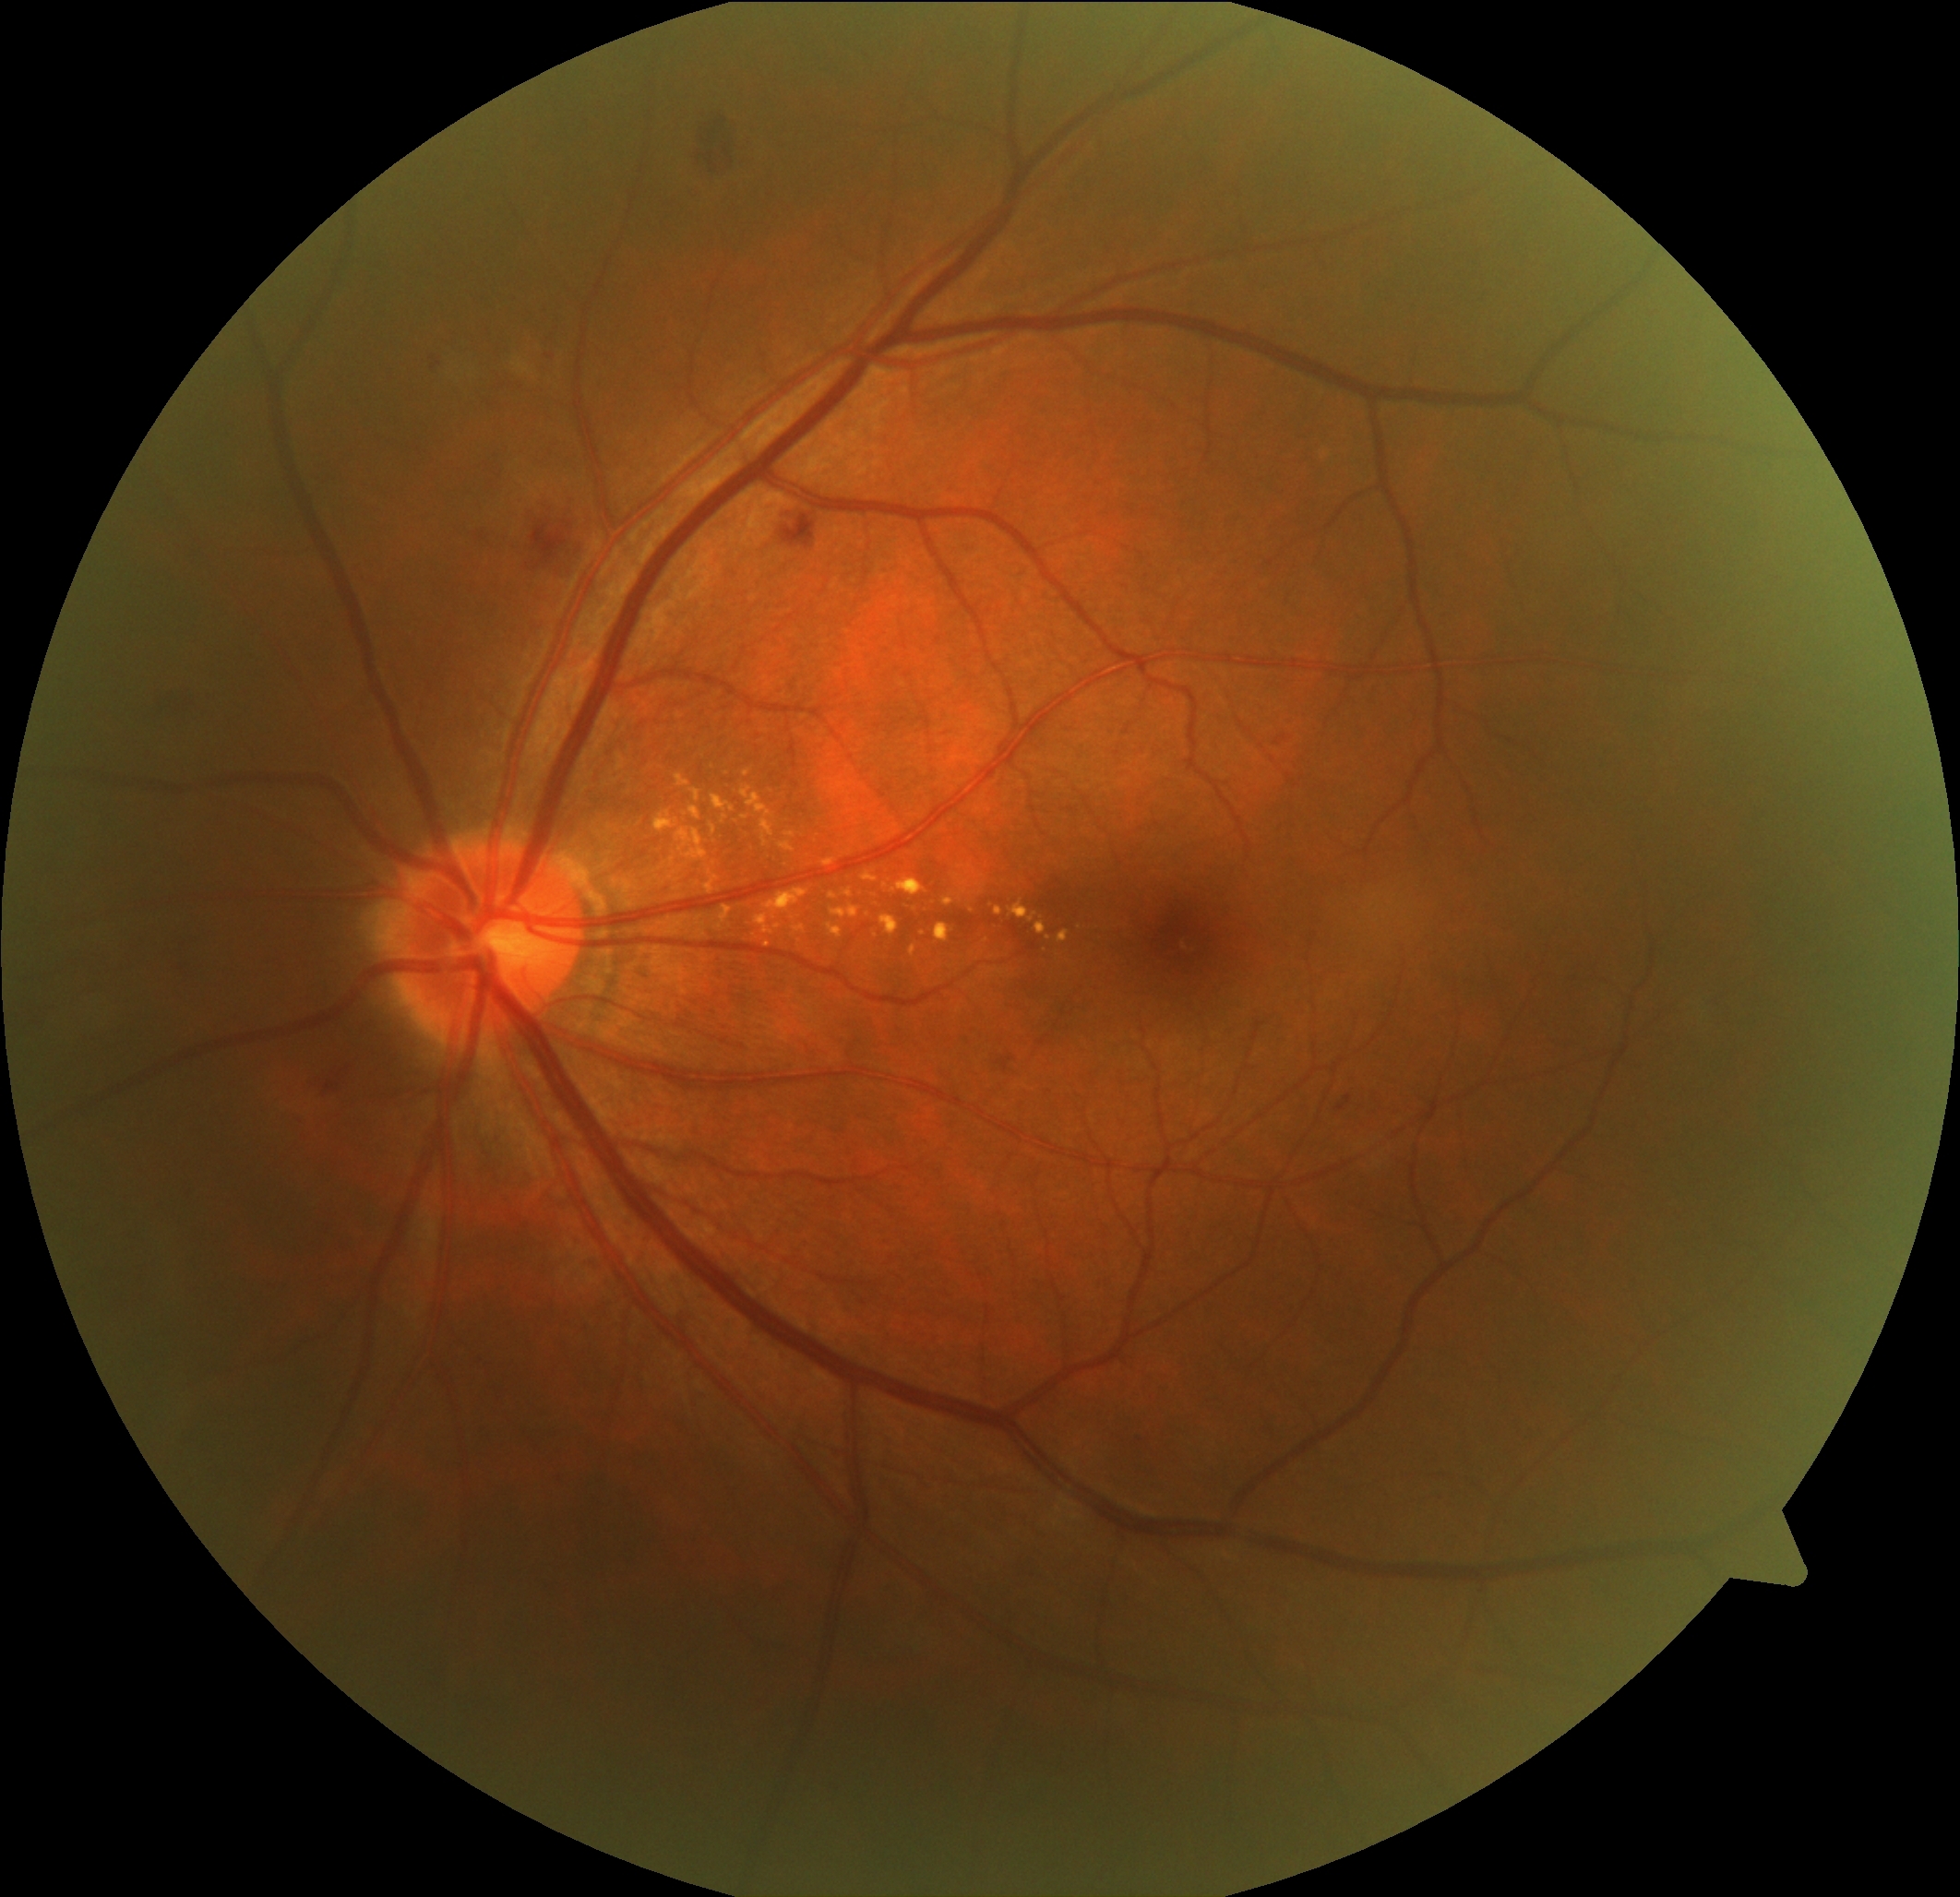 Retinopathy grade is 2/4 — more than just microaneurysms but less than severe NPDR; non-proliferative diabetic retinopathy
Selected lesions:
soft exudates: not present
hard exudates (continued): 911, 945, 917, 957; 689, 807, 702, 821; 741, 786, 775, 848; 513, 360, 532, 376; 892, 878, 926, 898; 1058, 932, 1070, 943; 722, 815, 729, 823; 712, 796, 735, 813; 831, 905, 859, 918; 779, 841, 796, 853; 829, 893, 839, 901; 675, 775, 691, 789; 944, 898, 955, 907; 825, 859, 834, 866
Smaller hard exudates around (748; 773); (1049; 939); (924; 934); (768; 945)
microaneurysms: not present
hemorrhages: 496, 490, 597, 580; 150, 683, 206, 723; 687, 113, 754, 179; 1337, 1096, 1353, 1112; 477, 532, 486, 540; 768, 504, 821, 552; 546, 354, 556, 360; 1274, 734, 1290, 746; 425, 352, 448, 376; 998, 1056, 1016, 1071; 299, 1058, 358, 1104
Smaller hemorrhages around (1139; 1442)